100° field of view (Phoenix ICON). Infant wide-field fundus photograph:
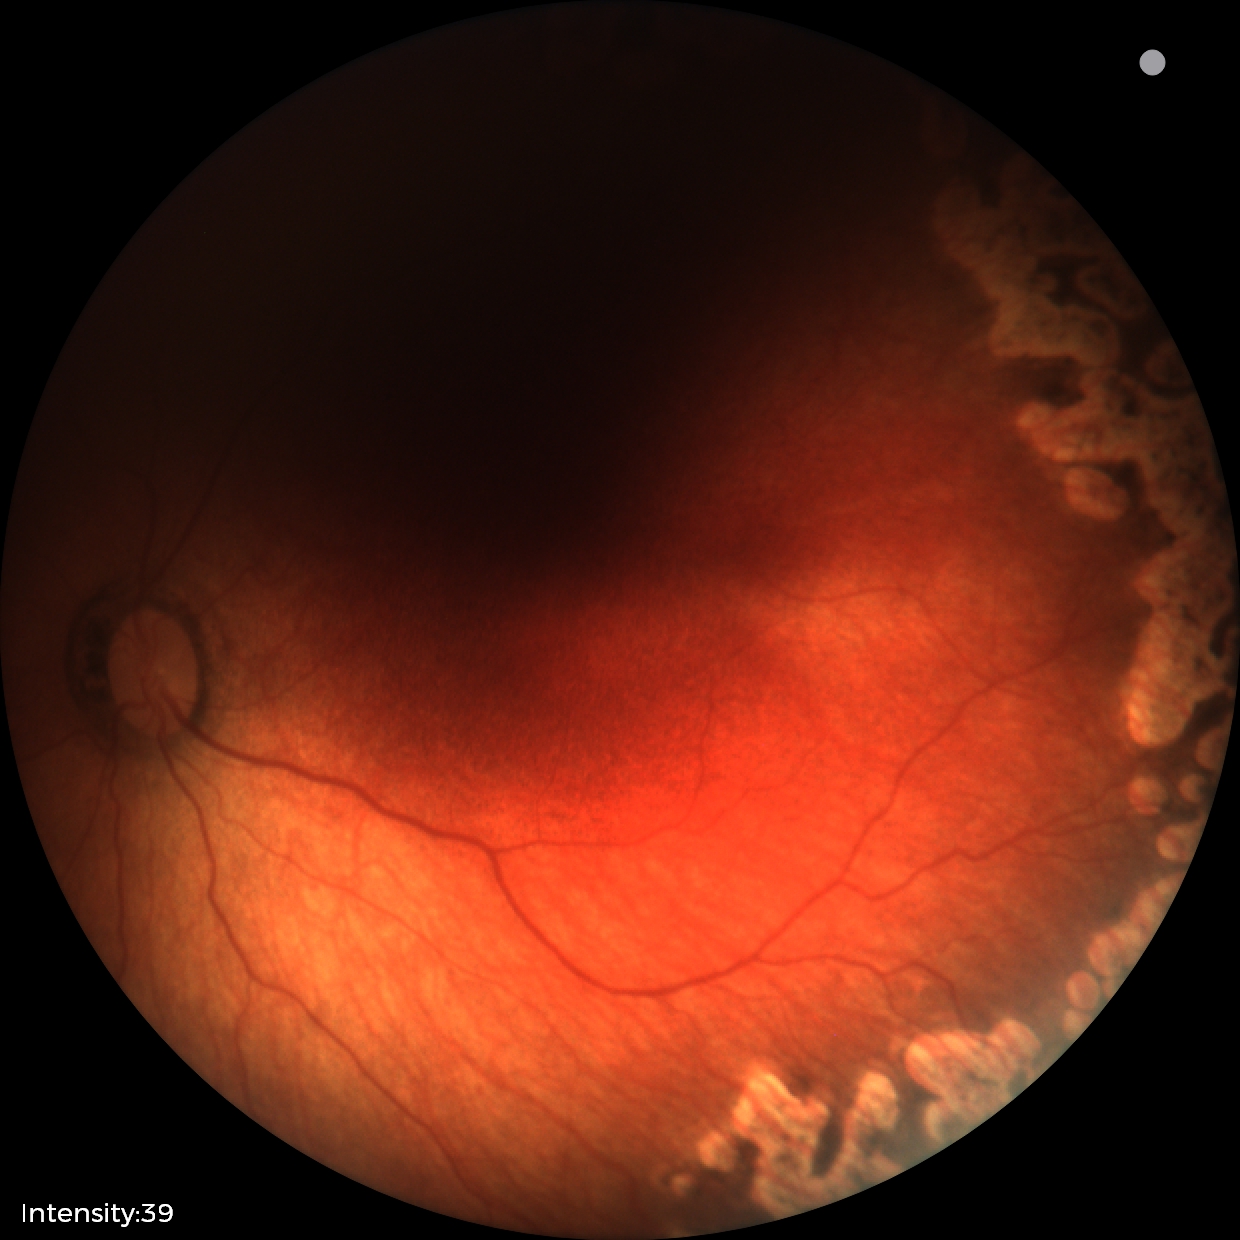
Screening examination consistent with status post retinopathy of prematurity. No plus disease.